2212 by 1659 pixels
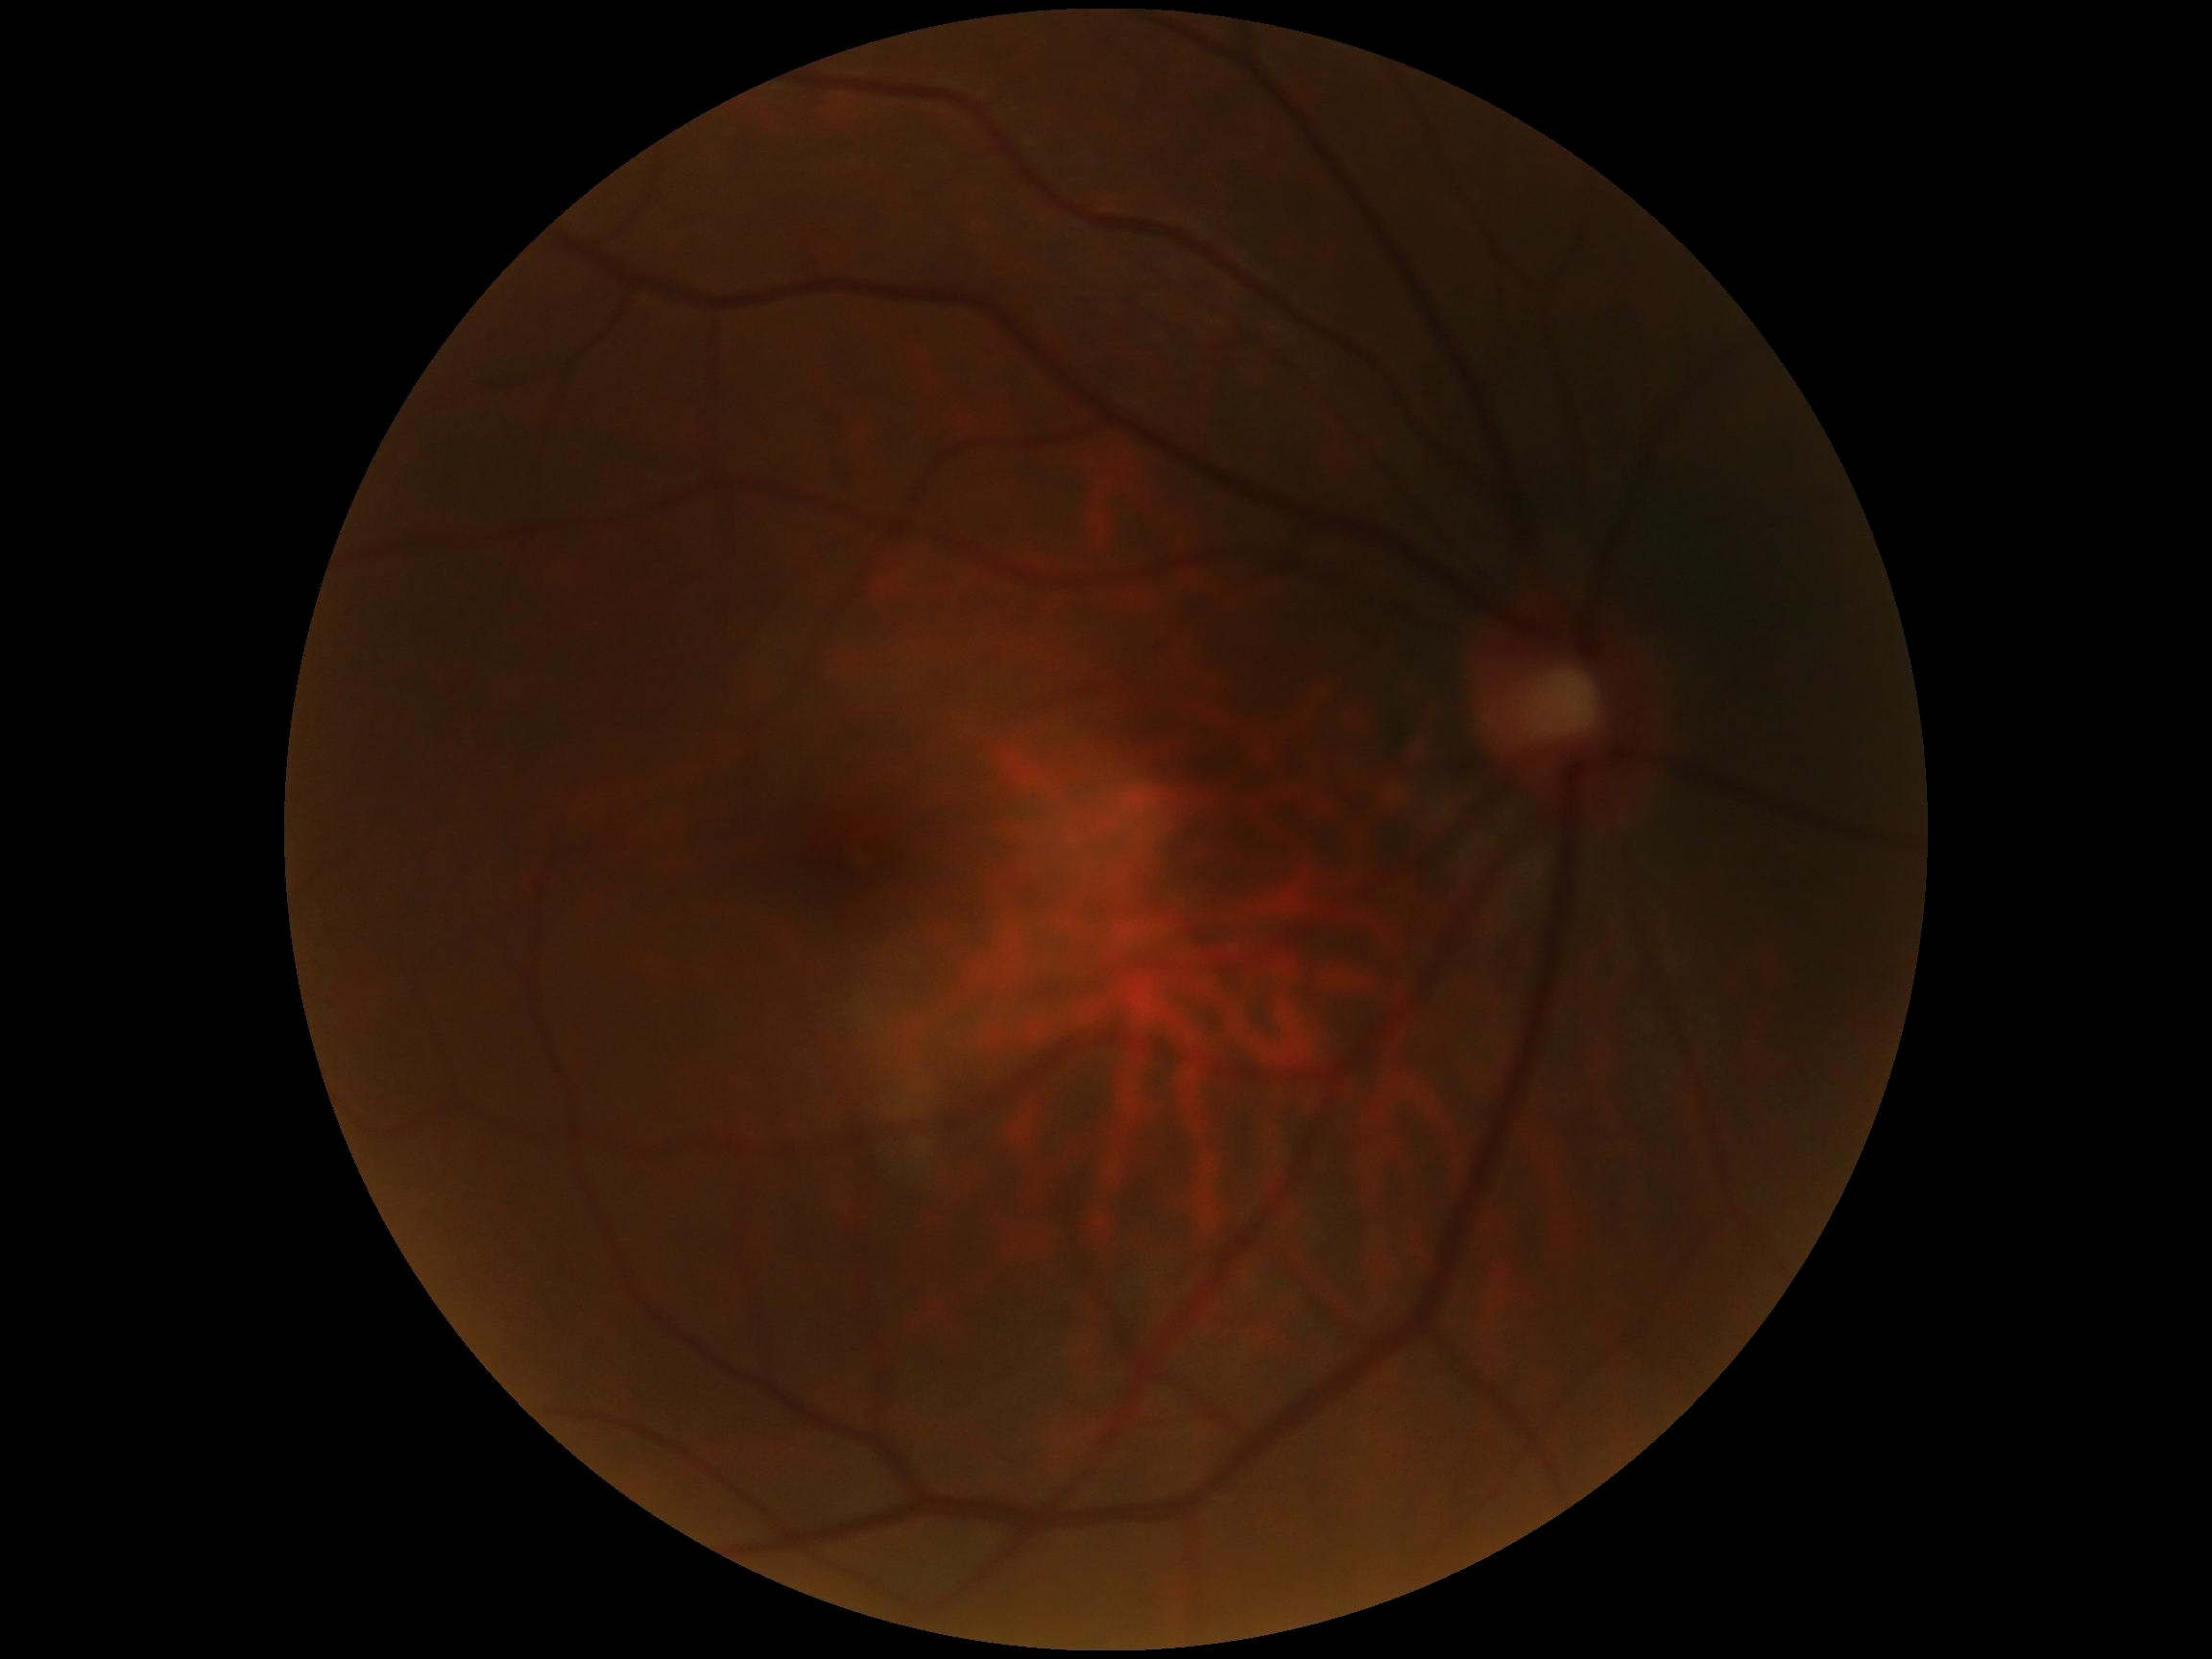 DR stage = 0 | DR impression = no apparent DR.